No pharmacologic dilation; modified Davis grading:
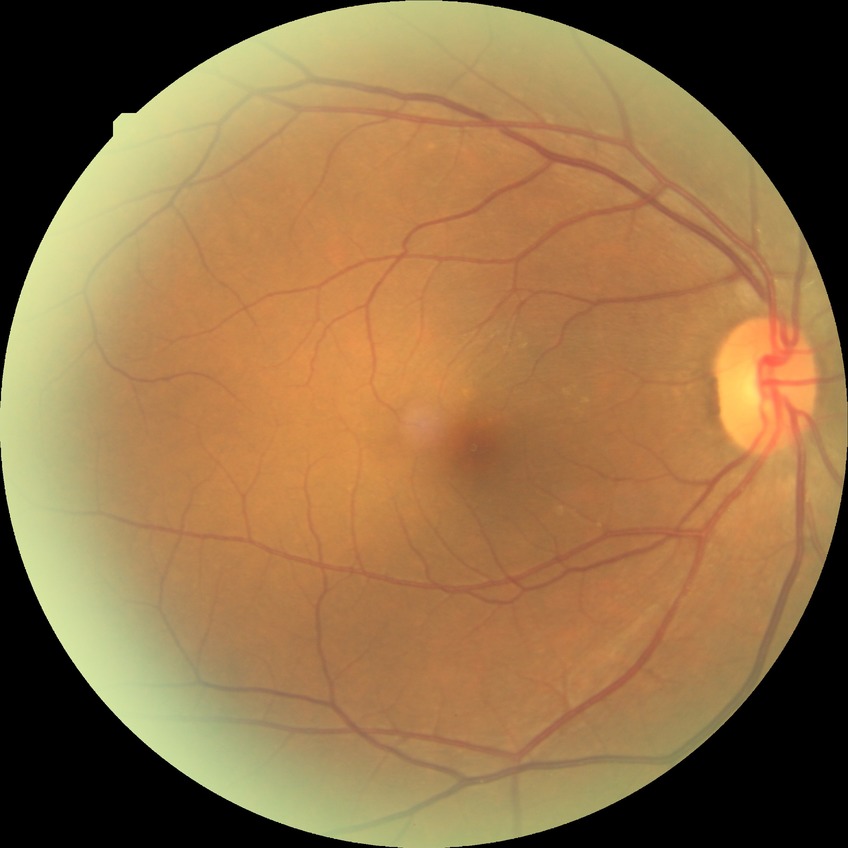 Diabetic retinopathy (DR) is no diabetic retinopathy (NDR).